Fundus photo: 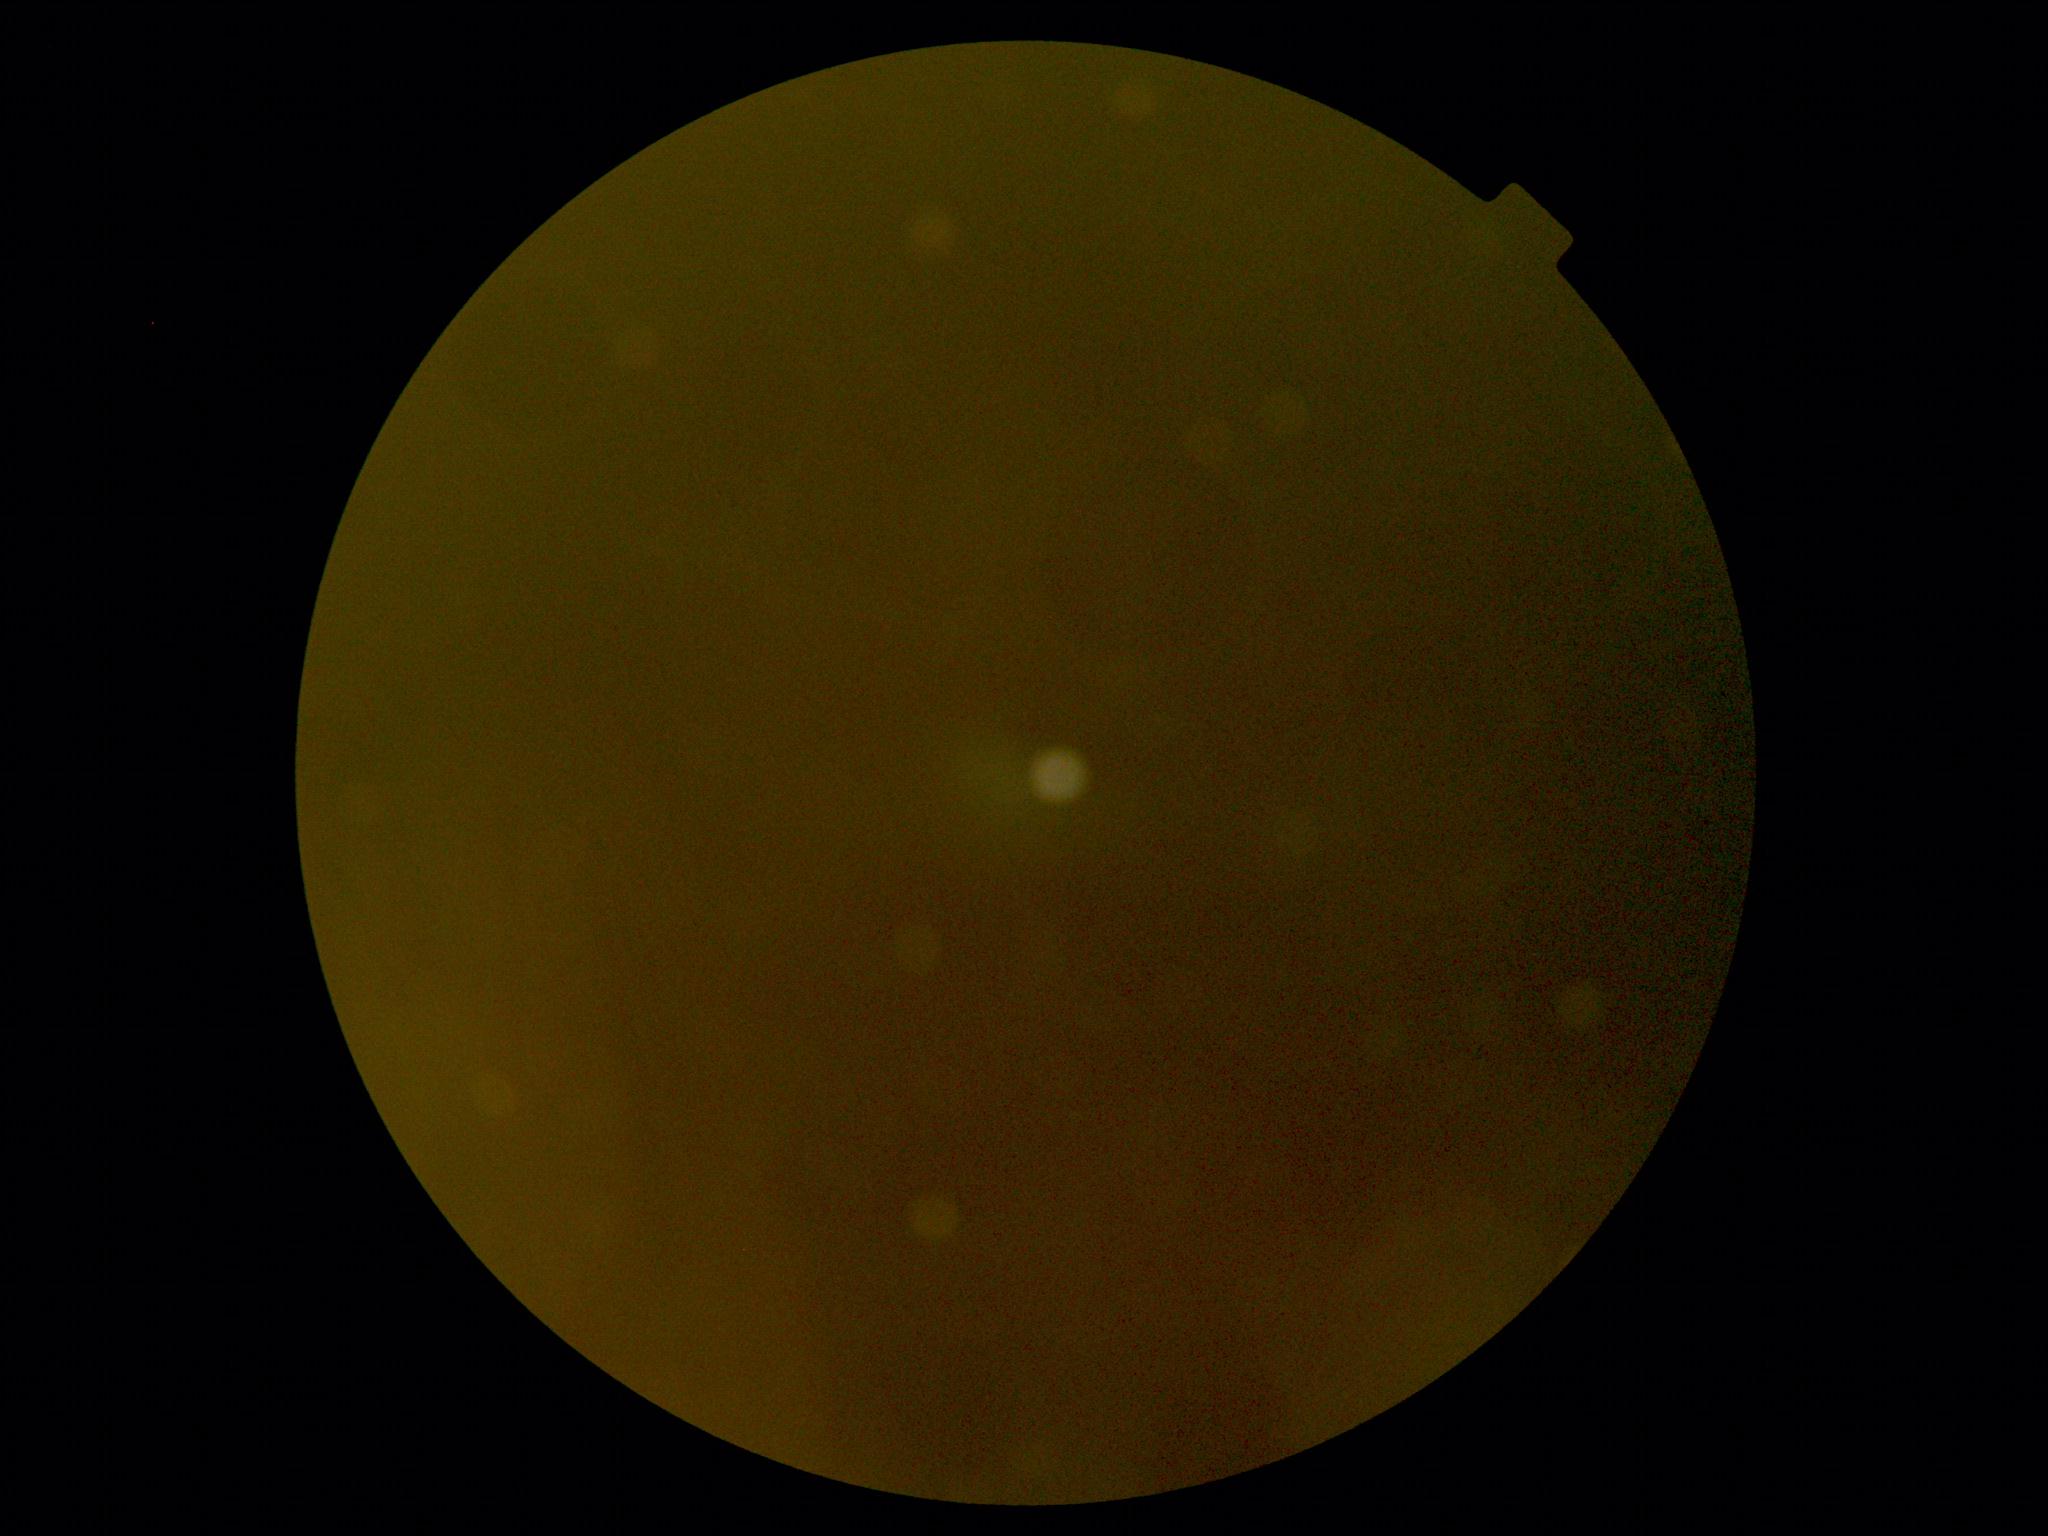 DR grade: ungradable.
The image cannot be graded for diabetic retinopathy.